Color fundus image. Nonmydriatic fundus photograph:
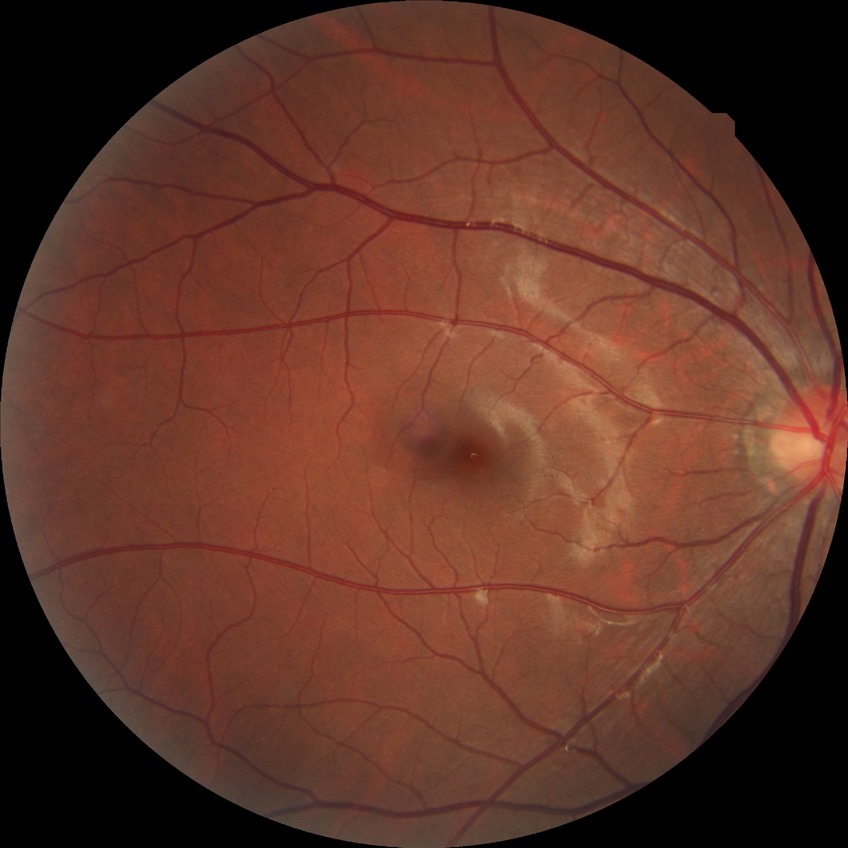

- DR: NDR